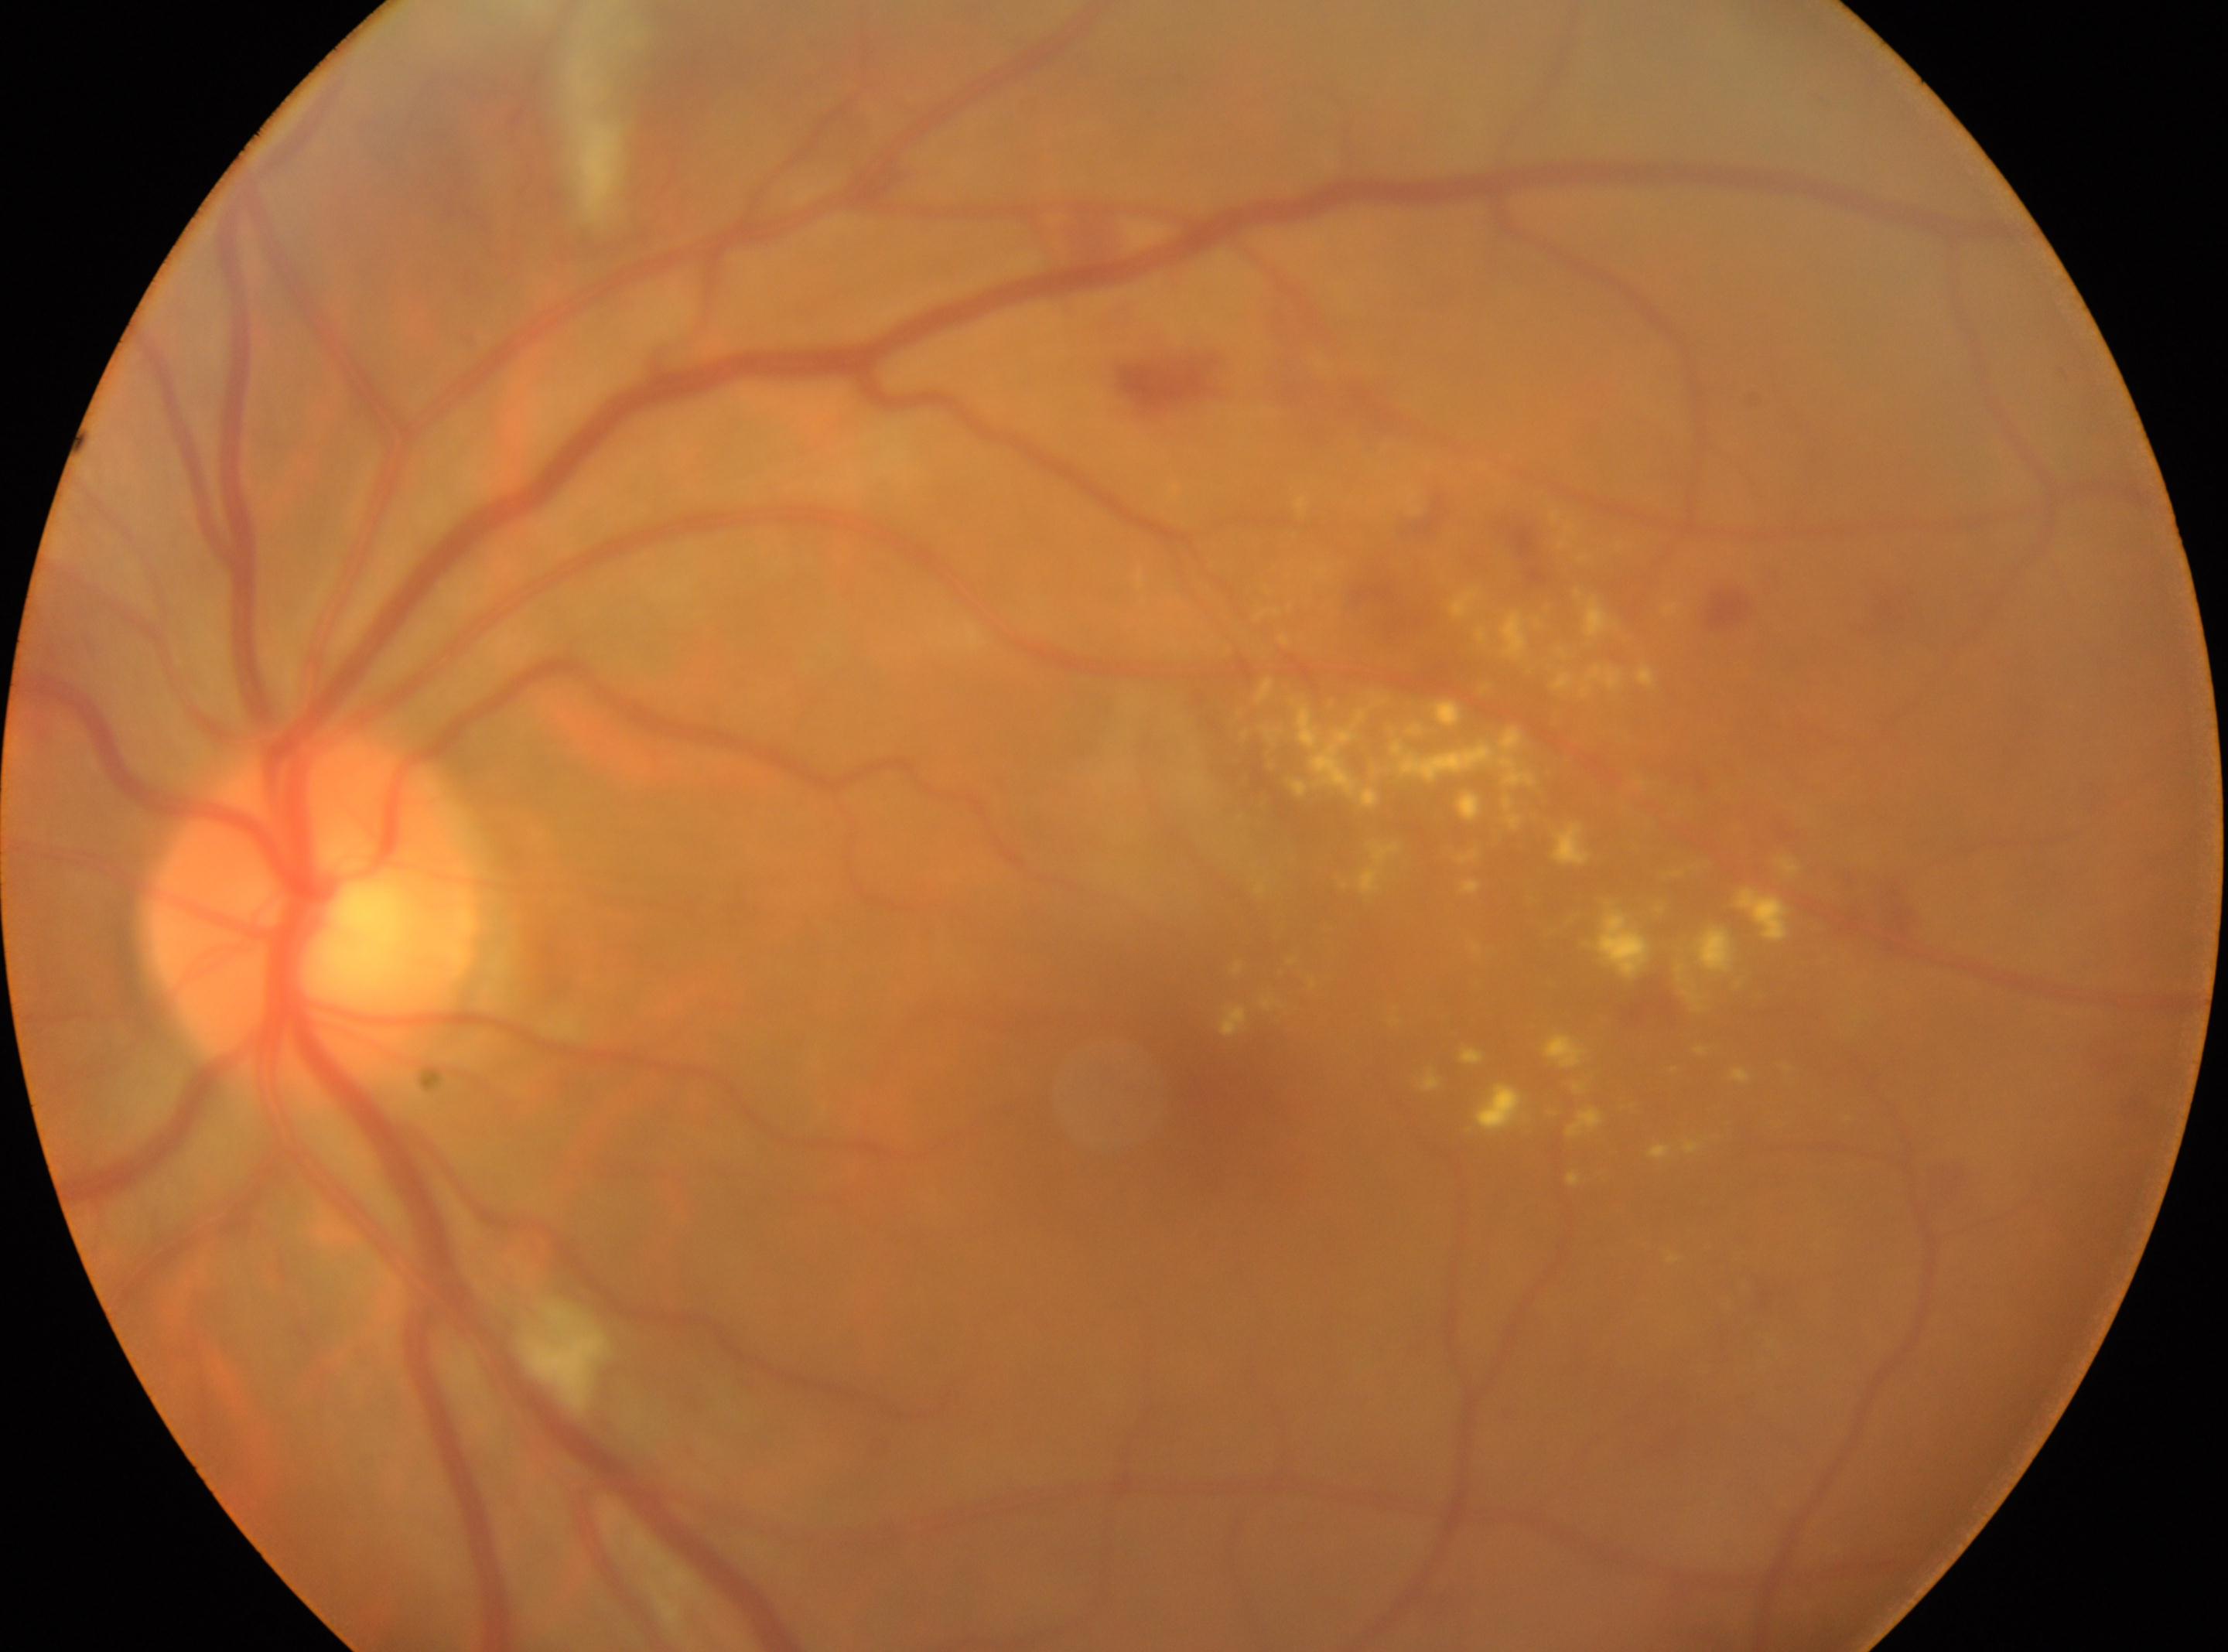
Optic disc located at x=316, y=913. This is the left eye. Fovea center: x=1185, y=1104. DR stage: grade 2 (moderate NPDR).